Graded on the modified Davis scale. NIDEK AFC-230 fundus camera. Nonmydriatic fundus photograph. 848x848: 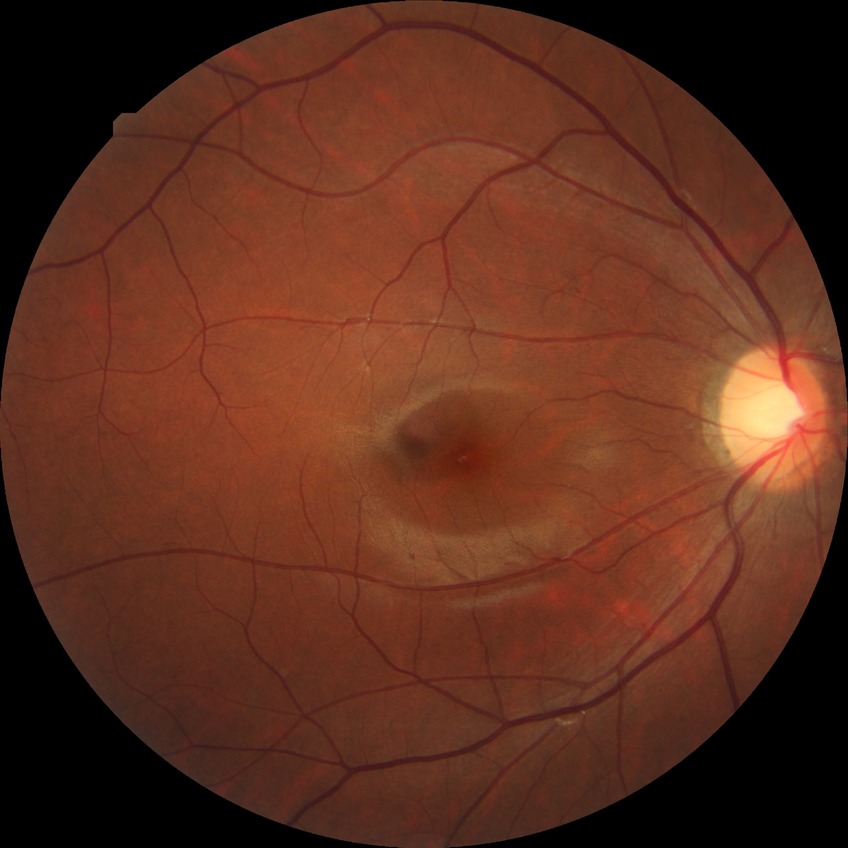
diabetic retinopathy (DR): NDR (no diabetic retinopathy)